Portable fundus camera image — 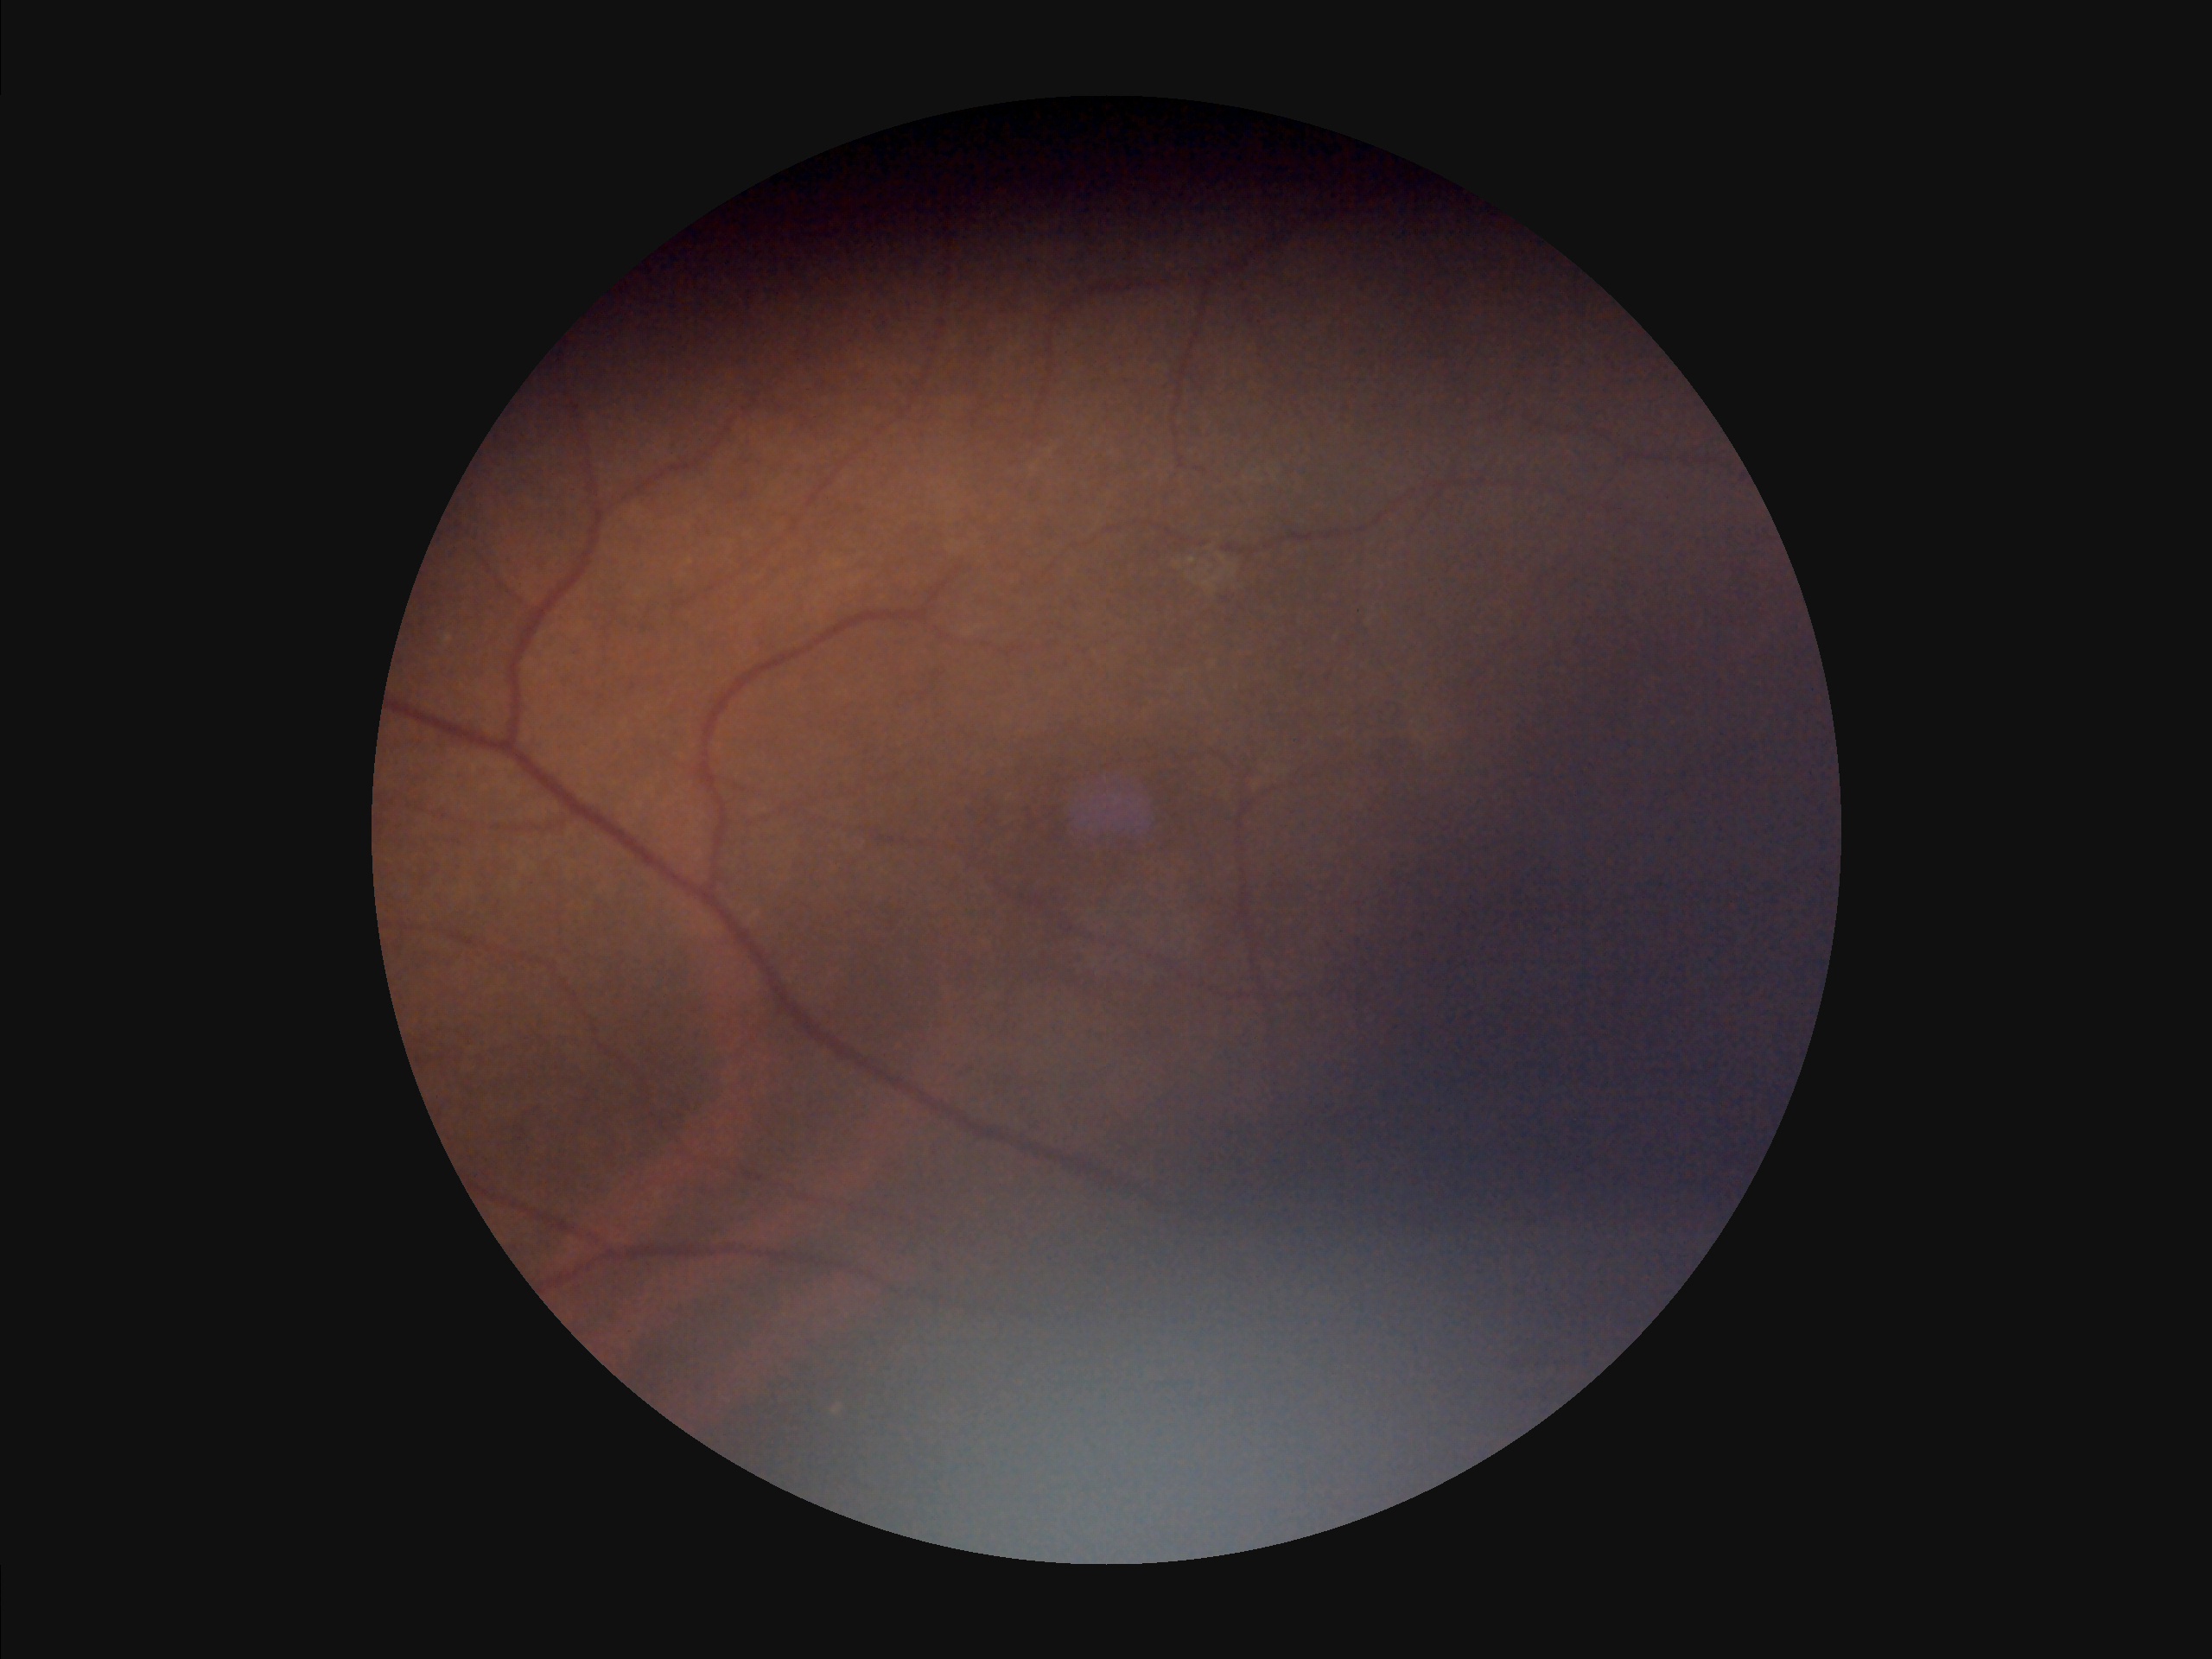

Clarity = out of focus, structures indistinct; Overall = poor, ungradable; Illumination = over- or under-exposed; Contrast = poor dynamic range.